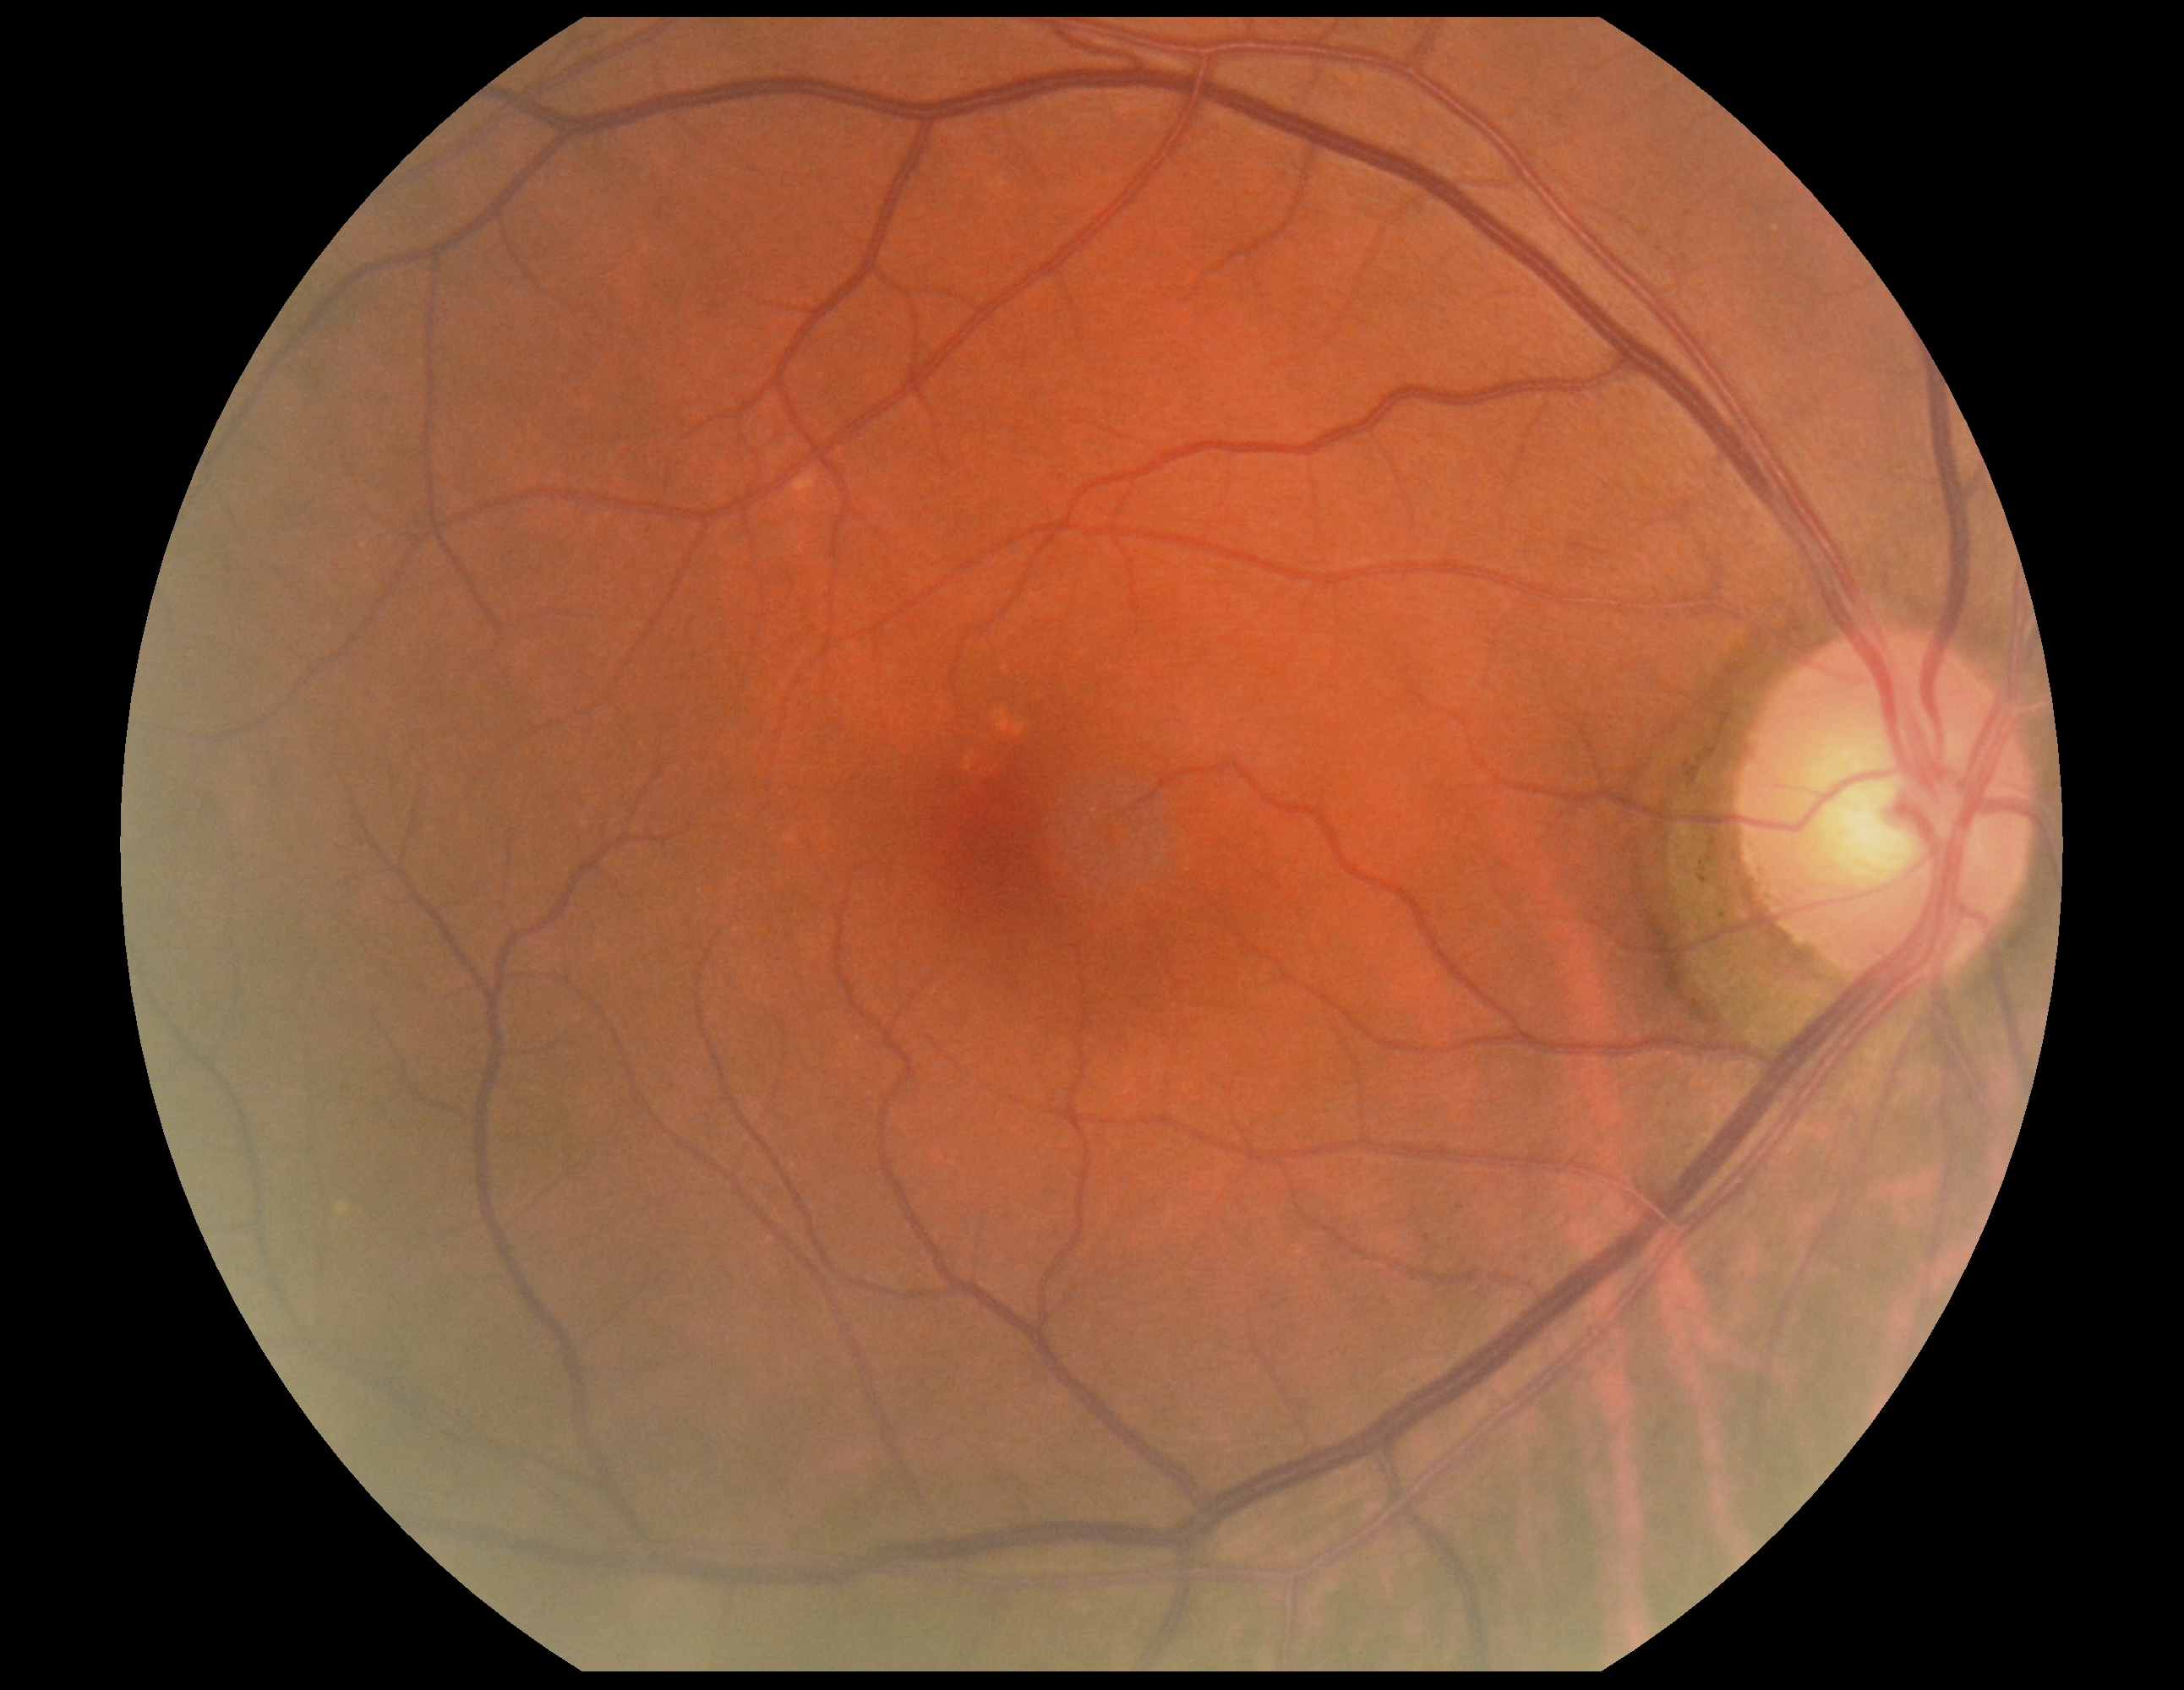

DR stage: no apparent diabetic retinopathy (grade 0) — no visible signs of diabetic retinopathy.